Fundus photo. 2352x1568px. 45-degree field of view: 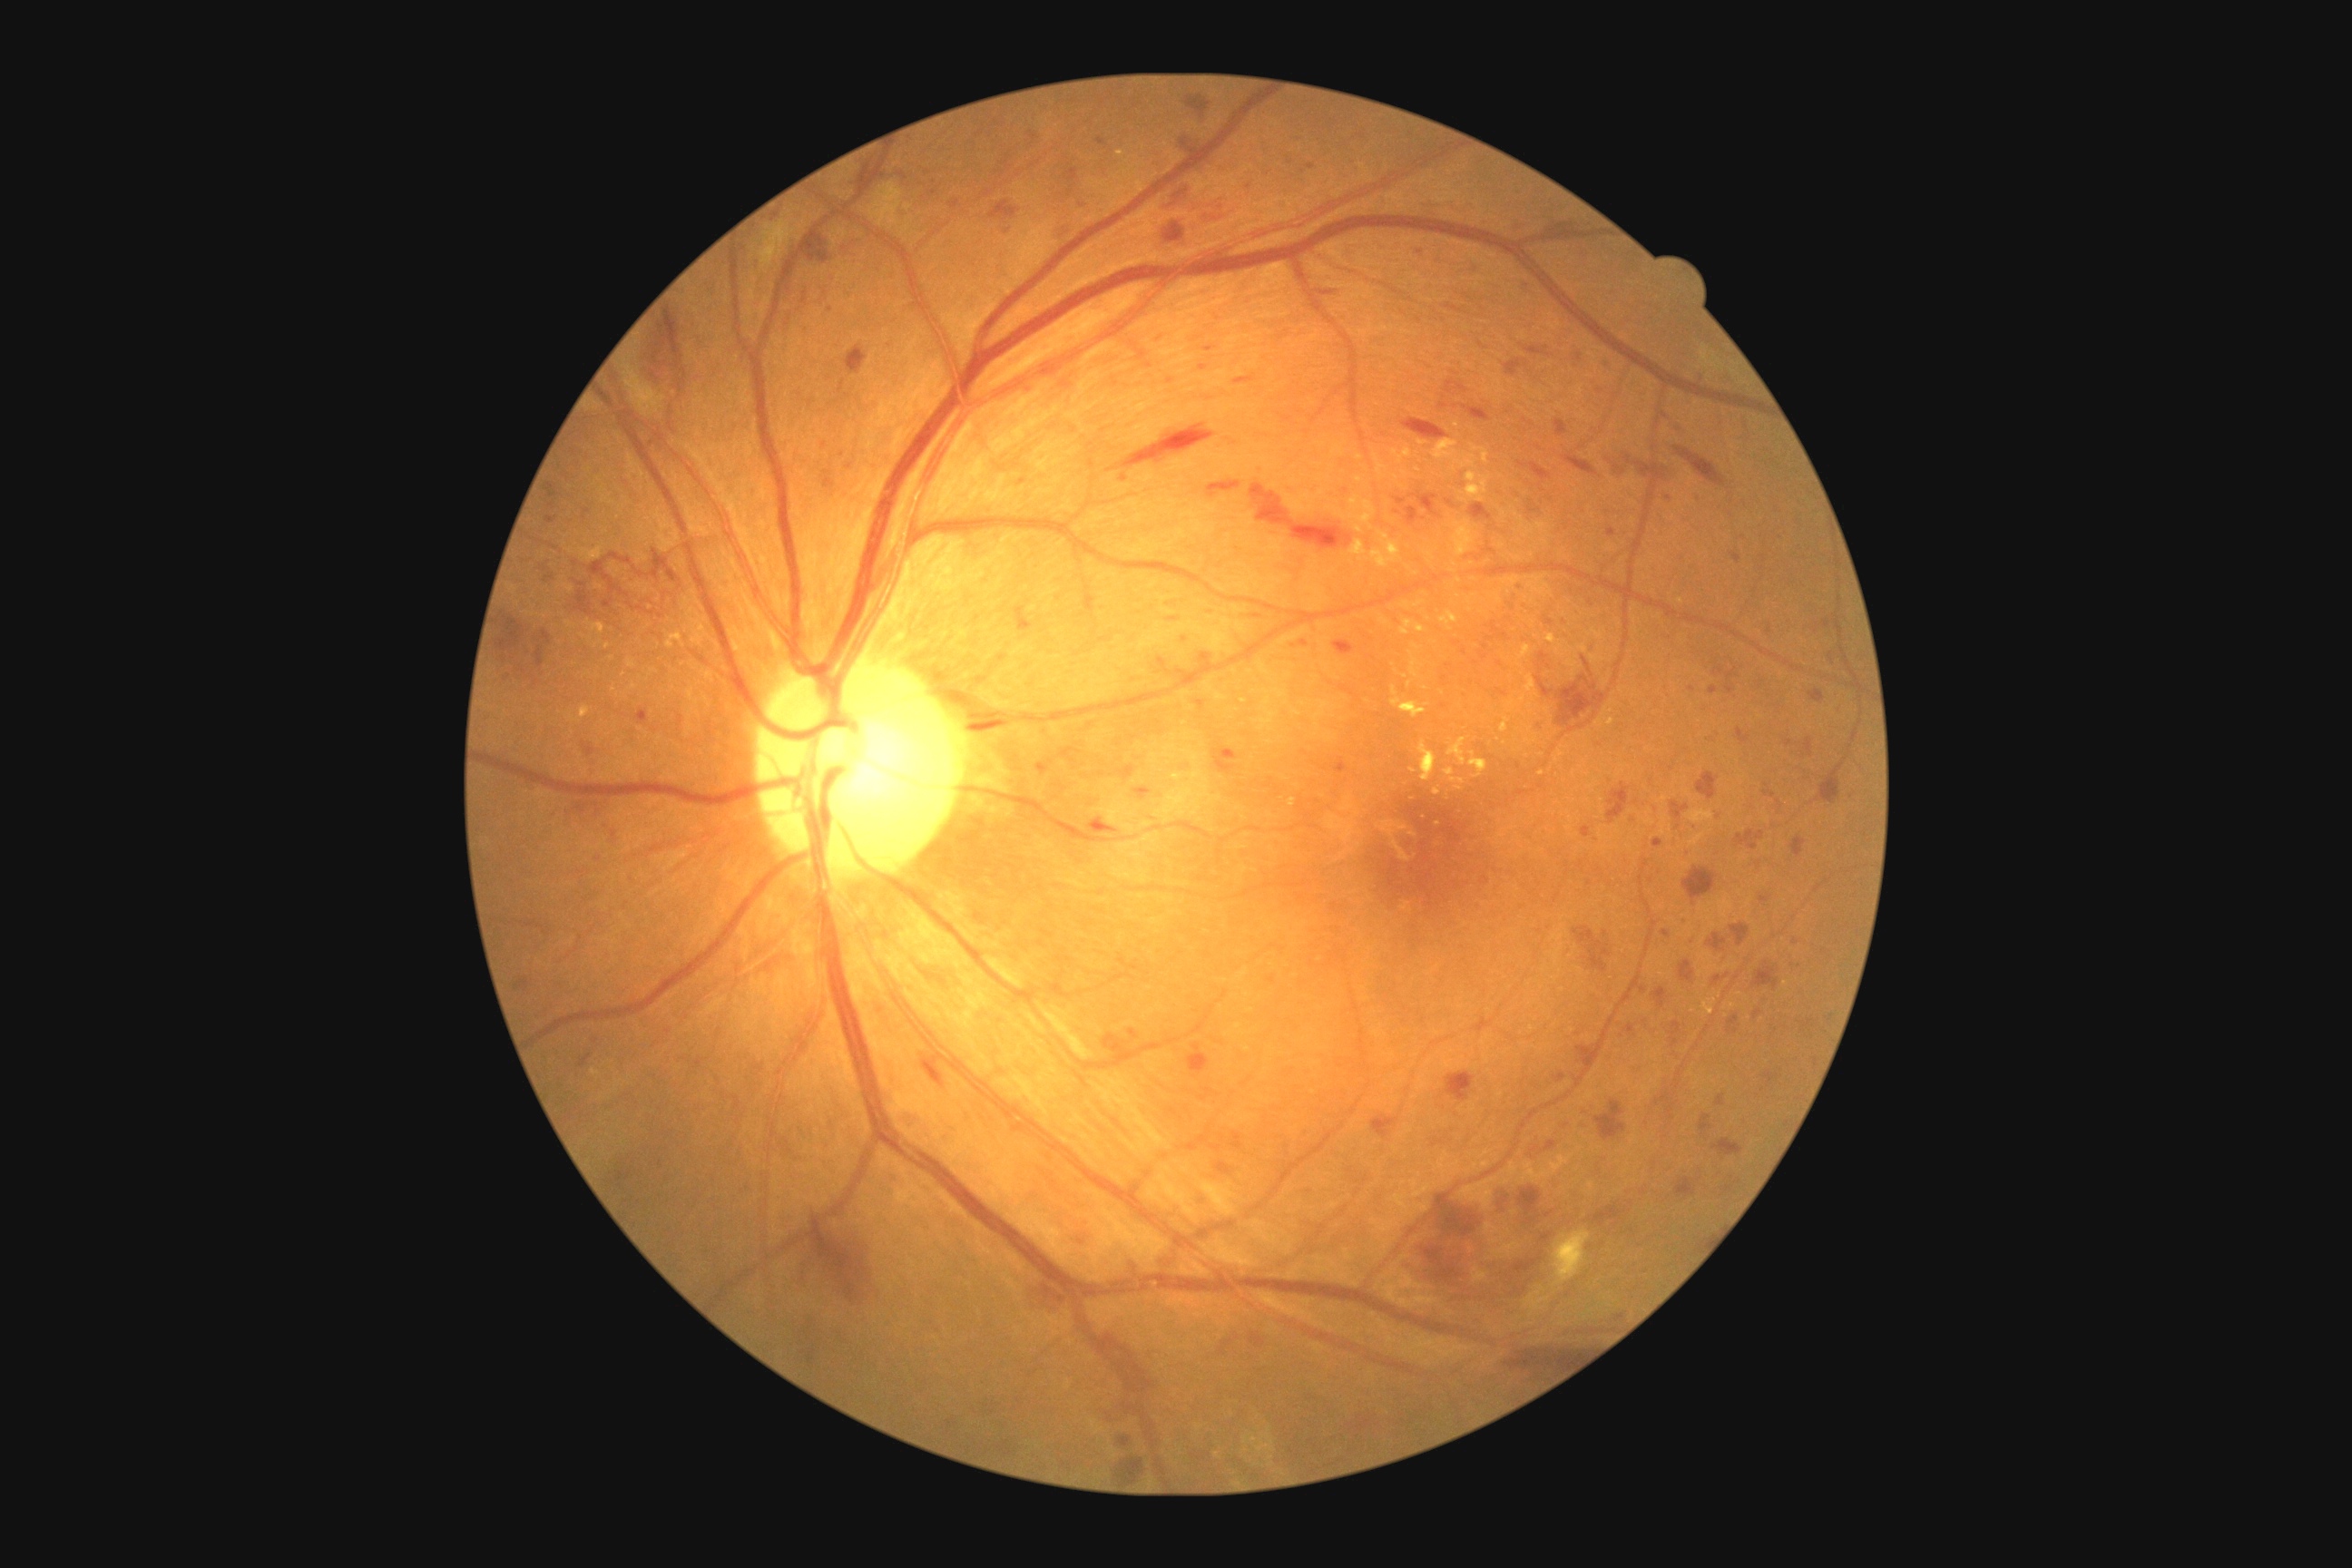

Diabetic retinopathy (DR) is 3
A subset of detected lesions:
hemorrhages (HEs) (continued): rect(1596, 1101, 1625, 1142) | rect(1759, 896, 1772, 903) | rect(1231, 1133, 1242, 1150) | rect(1004, 162, 1012, 170) | rect(1818, 781, 1839, 801) | rect(803, 231, 828, 266) | rect(1073, 201, 1088, 210) | rect(1371, 1115, 1398, 1139) | rect(1714, 974, 1730, 986) | rect(1671, 1023, 1681, 1048) | rect(1518, 462, 1553, 482) | rect(1707, 934, 1727, 950) | rect(1558, 674, 1607, 732) | rect(1553, 220, 1573, 231) | rect(1333, 640, 1355, 656) | rect(1752, 1010, 1763, 1021) | rect(571, 805, 607, 819) | rect(1582, 656, 1594, 676) | rect(1520, 280, 1527, 289)
Small HEs near x=1778 y=804